FOV: 45 degrees · without pupil dilation
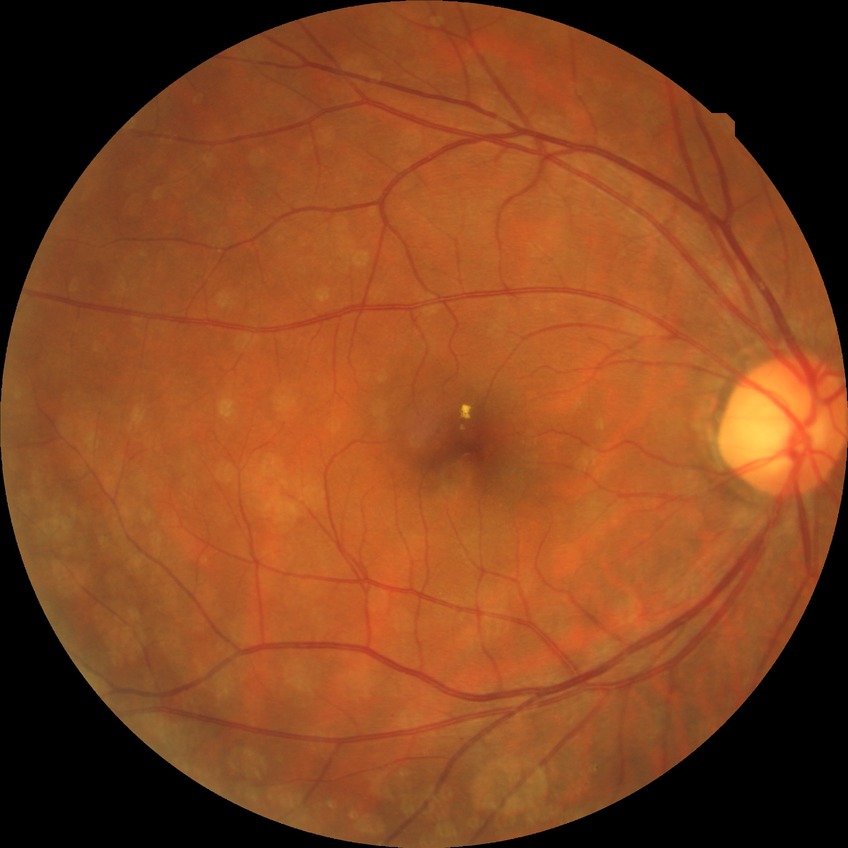

davis_grade: simple diabetic retinopathy